1240x1240px · camera: Phoenix ICON (100° FOV) · infant wide-field fundus photograph.
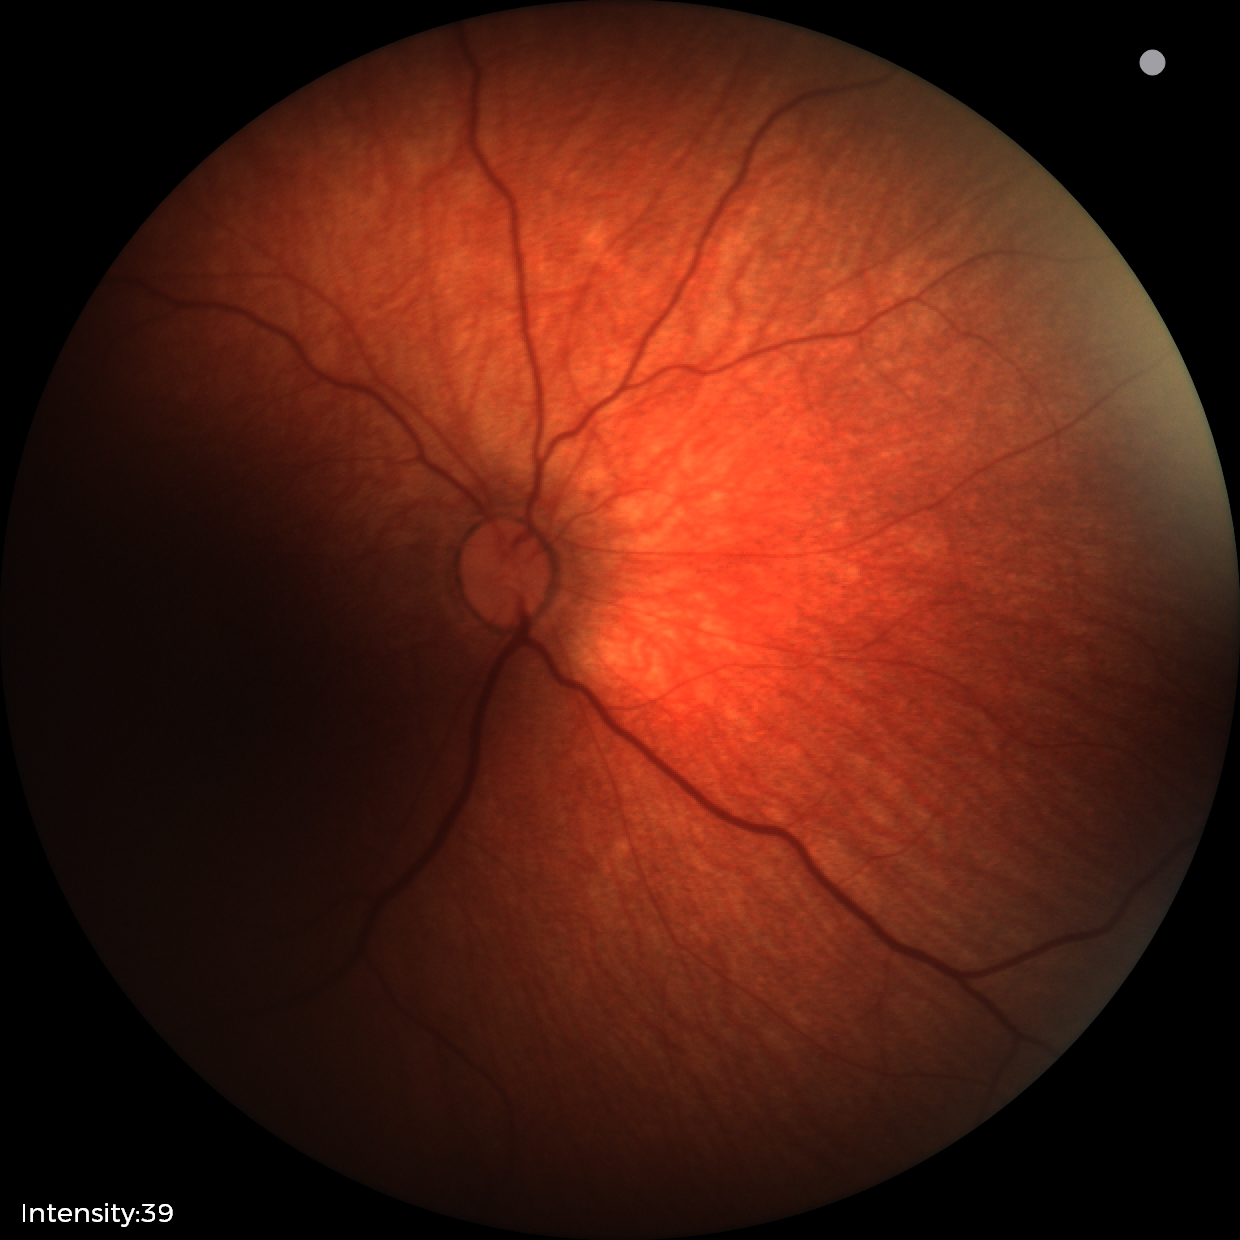 Screening examination with no abnormal retinal findings.